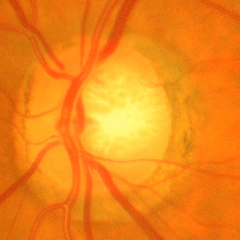
Advanced glaucomatous optic neuropathy.
Diagnostic criteria: near-total cupping of the optic nerve head, with or without severe visual field loss within the central 10 degrees of fixation.